45-degree field of view, 2352x1568 — 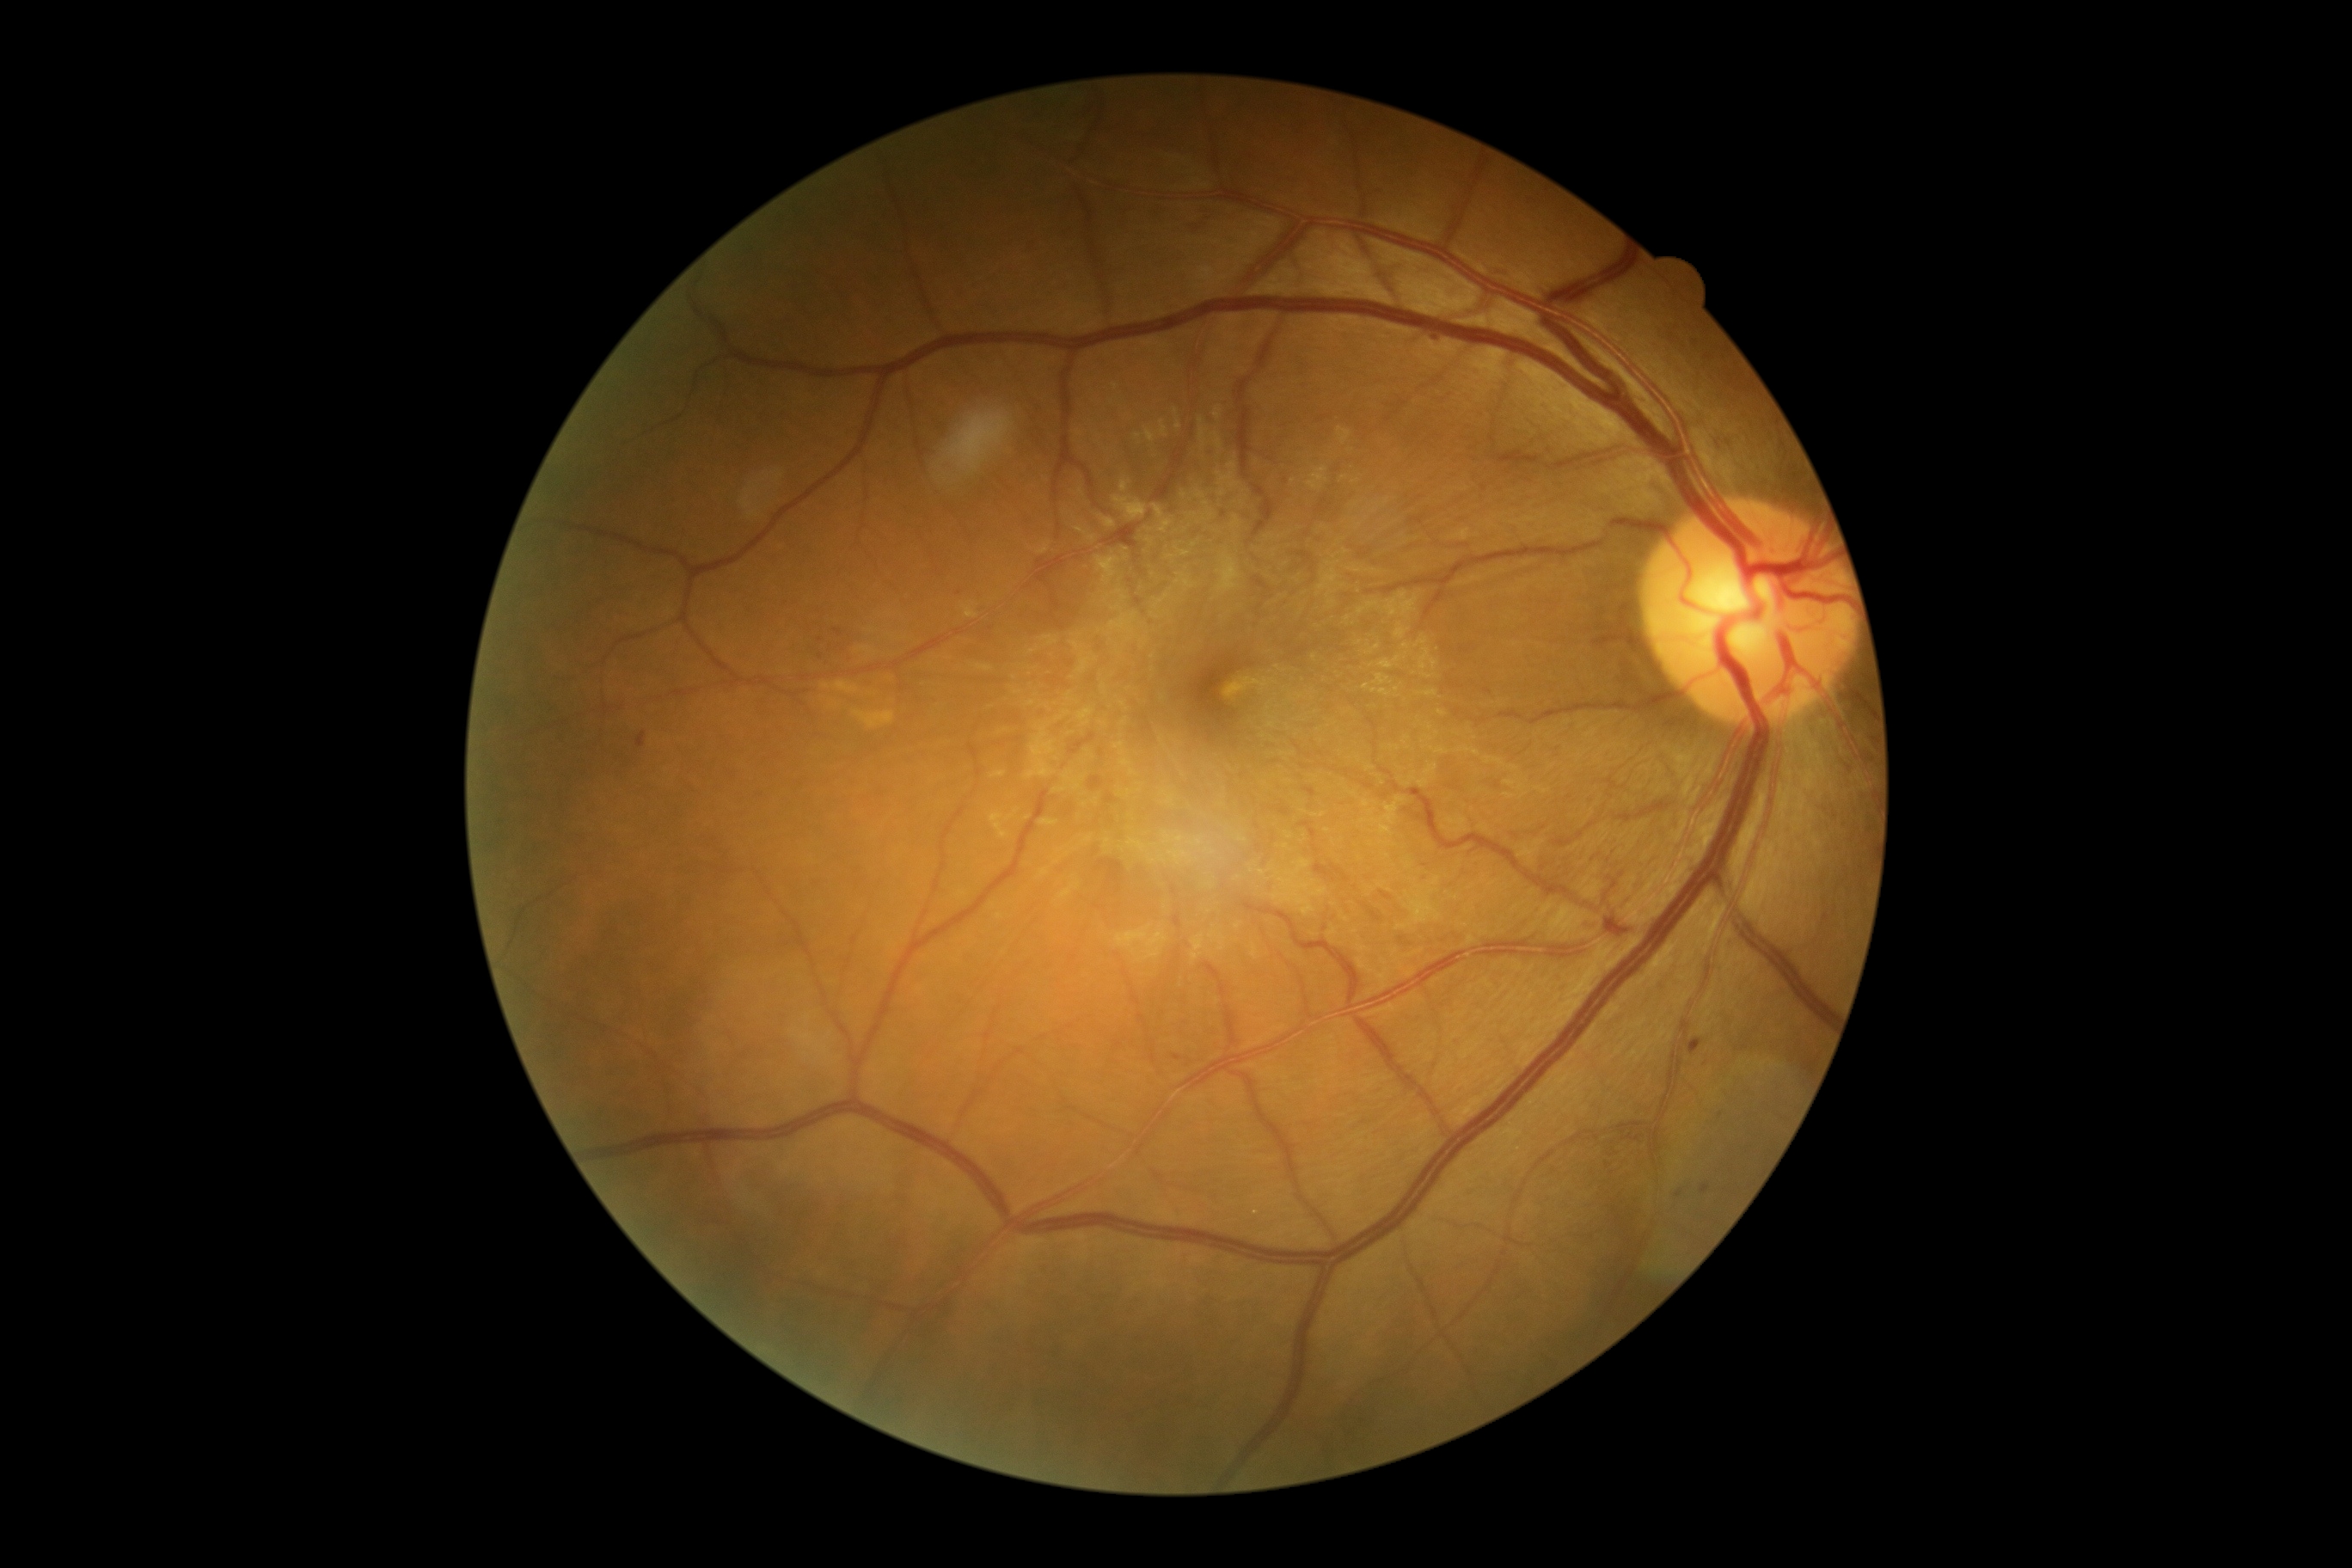
DR severity: grade 1 (mild NPDR)
SEs: not present
MAs: (637, 732, 646, 749), (1694, 1038, 1700, 1048), (1173, 1057, 1182, 1062), (1701, 1185, 1712, 1194), (835, 628, 842, 637)
MAs (small, approximate centers) near <point>1678, 1194</point>, <point>1437, 338</point>, <point>821, 640</point>, <point>960, 594</point>, <point>821, 656</point>
HEs: not present
EXs: not present